Remidio FOP fundus camera, image size 1659x2212: 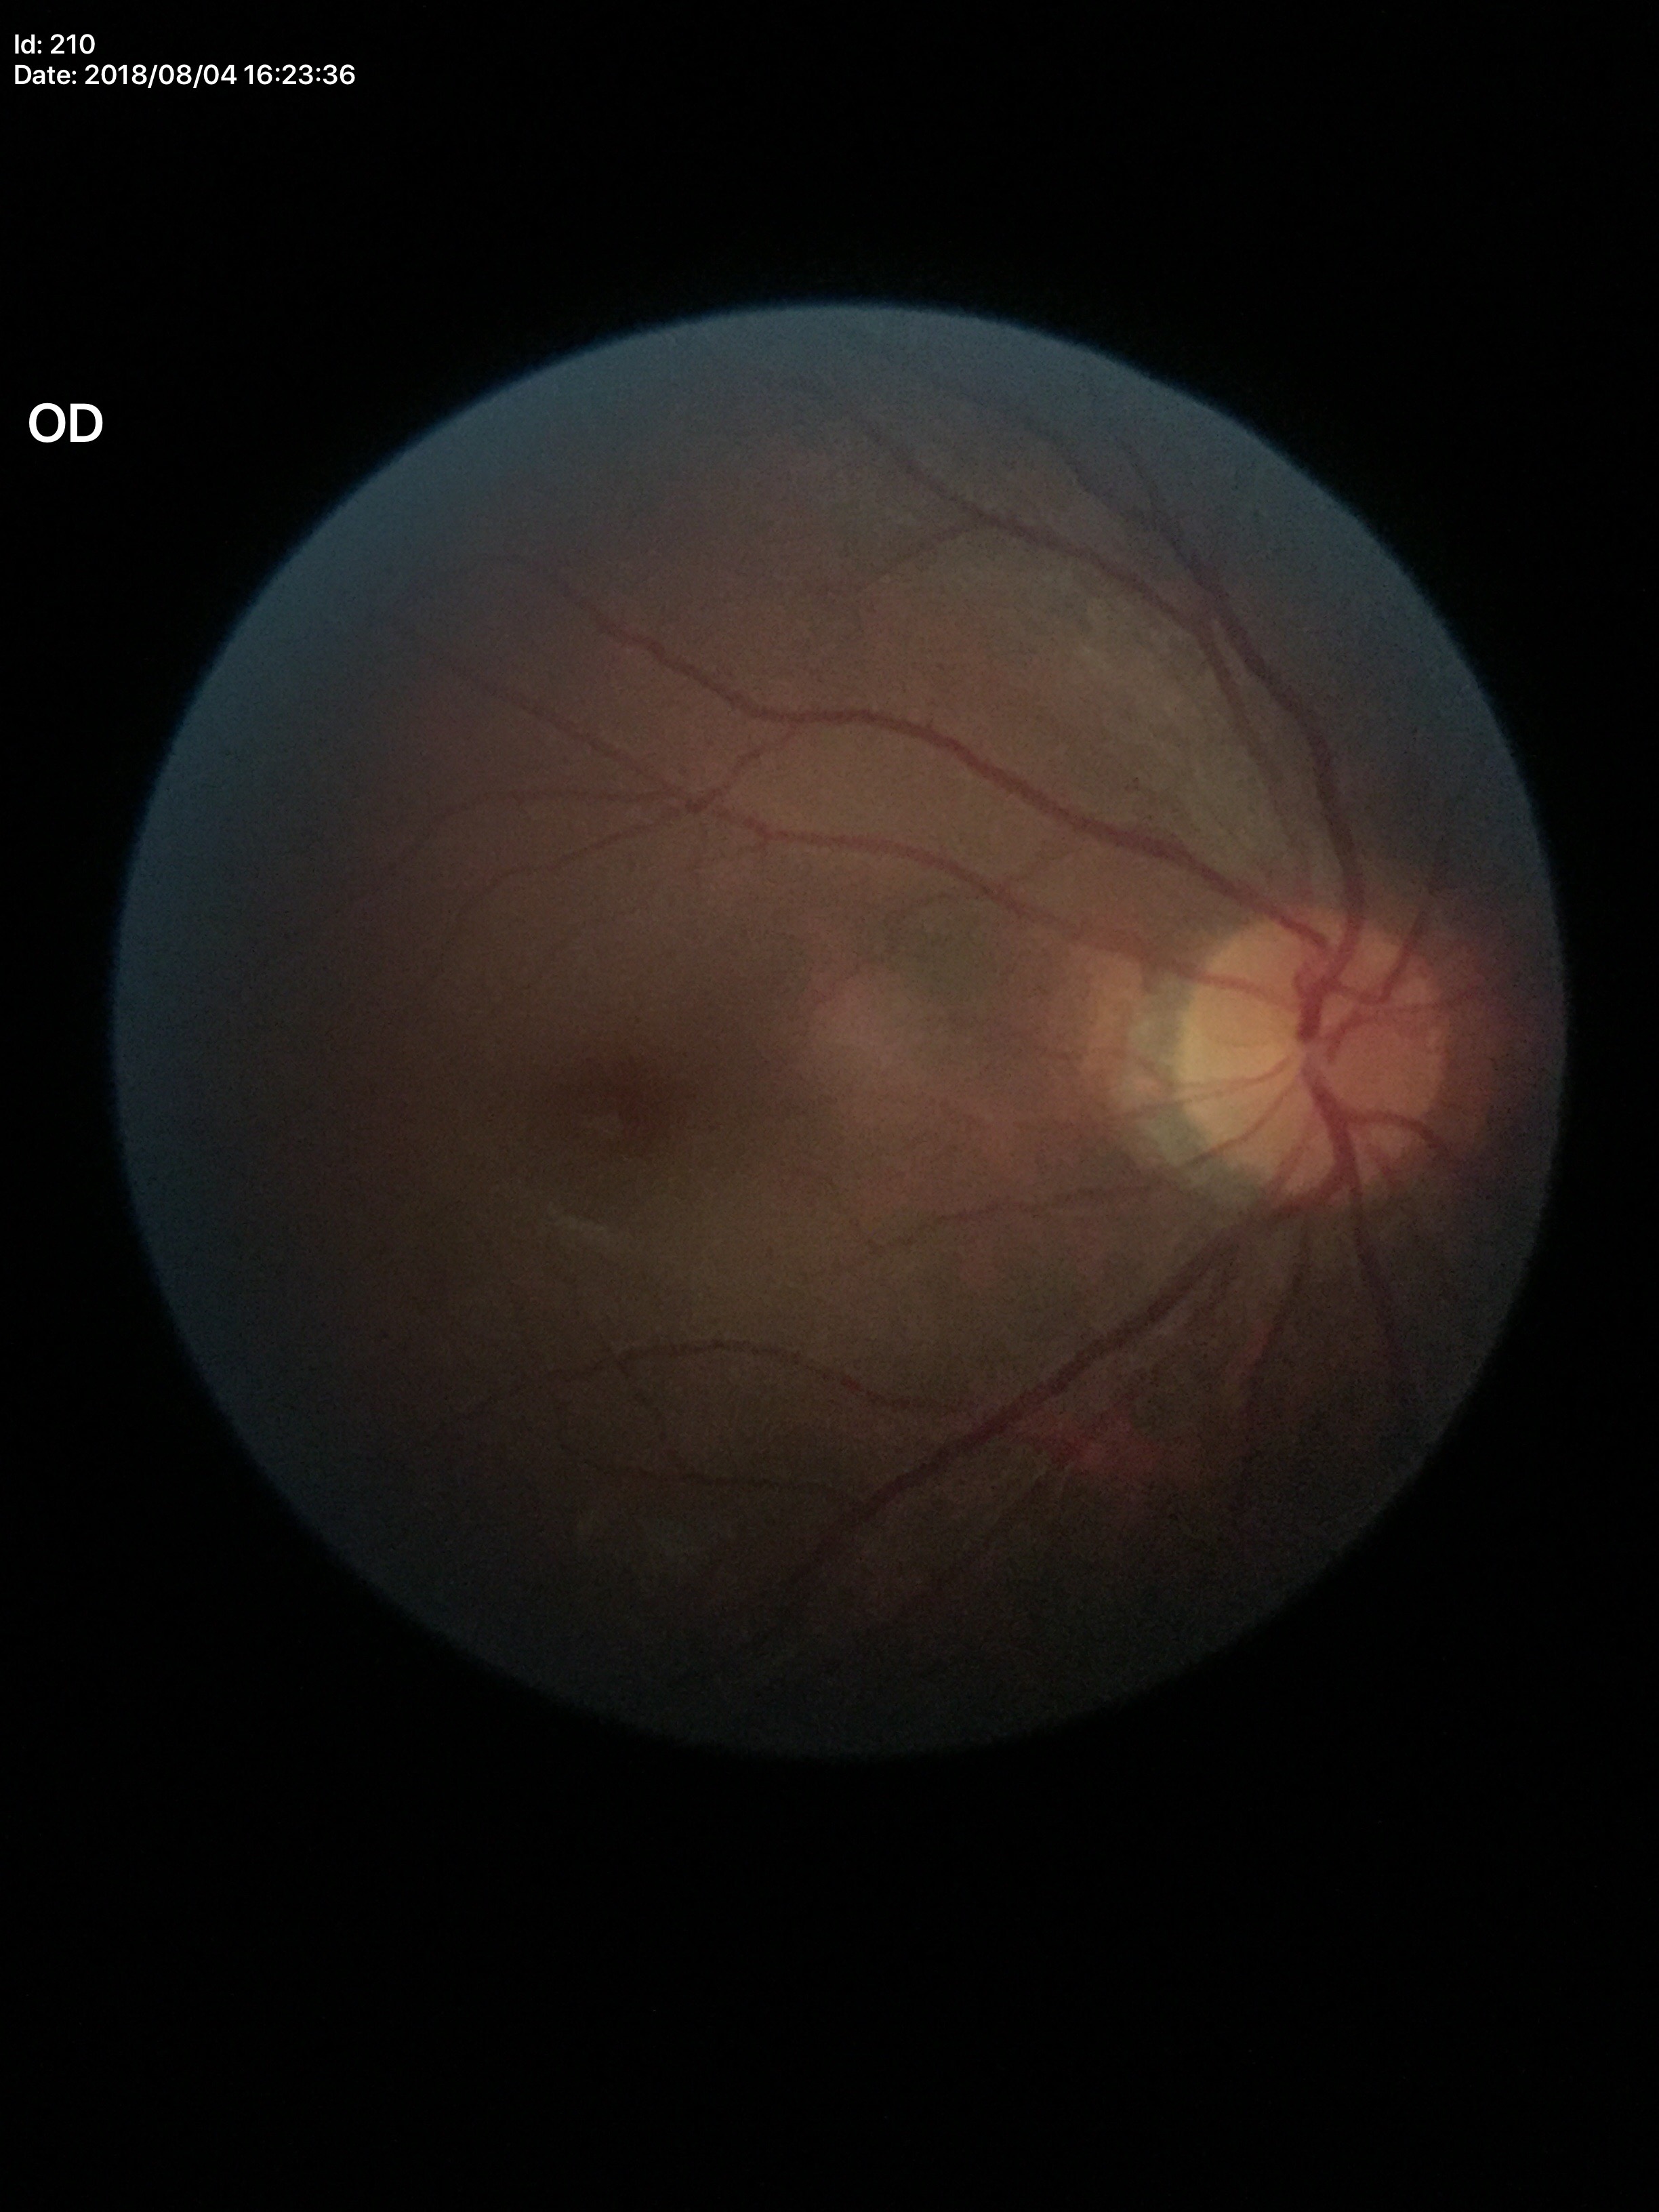
Glaucoma screening impression: no suspicious findings (5/5 ophthalmologists in agreement).
Horizontal cup-disc ratio (HCDR) is 0.47.
Vertical cup-to-disc ratio (VCDR): 0.47.